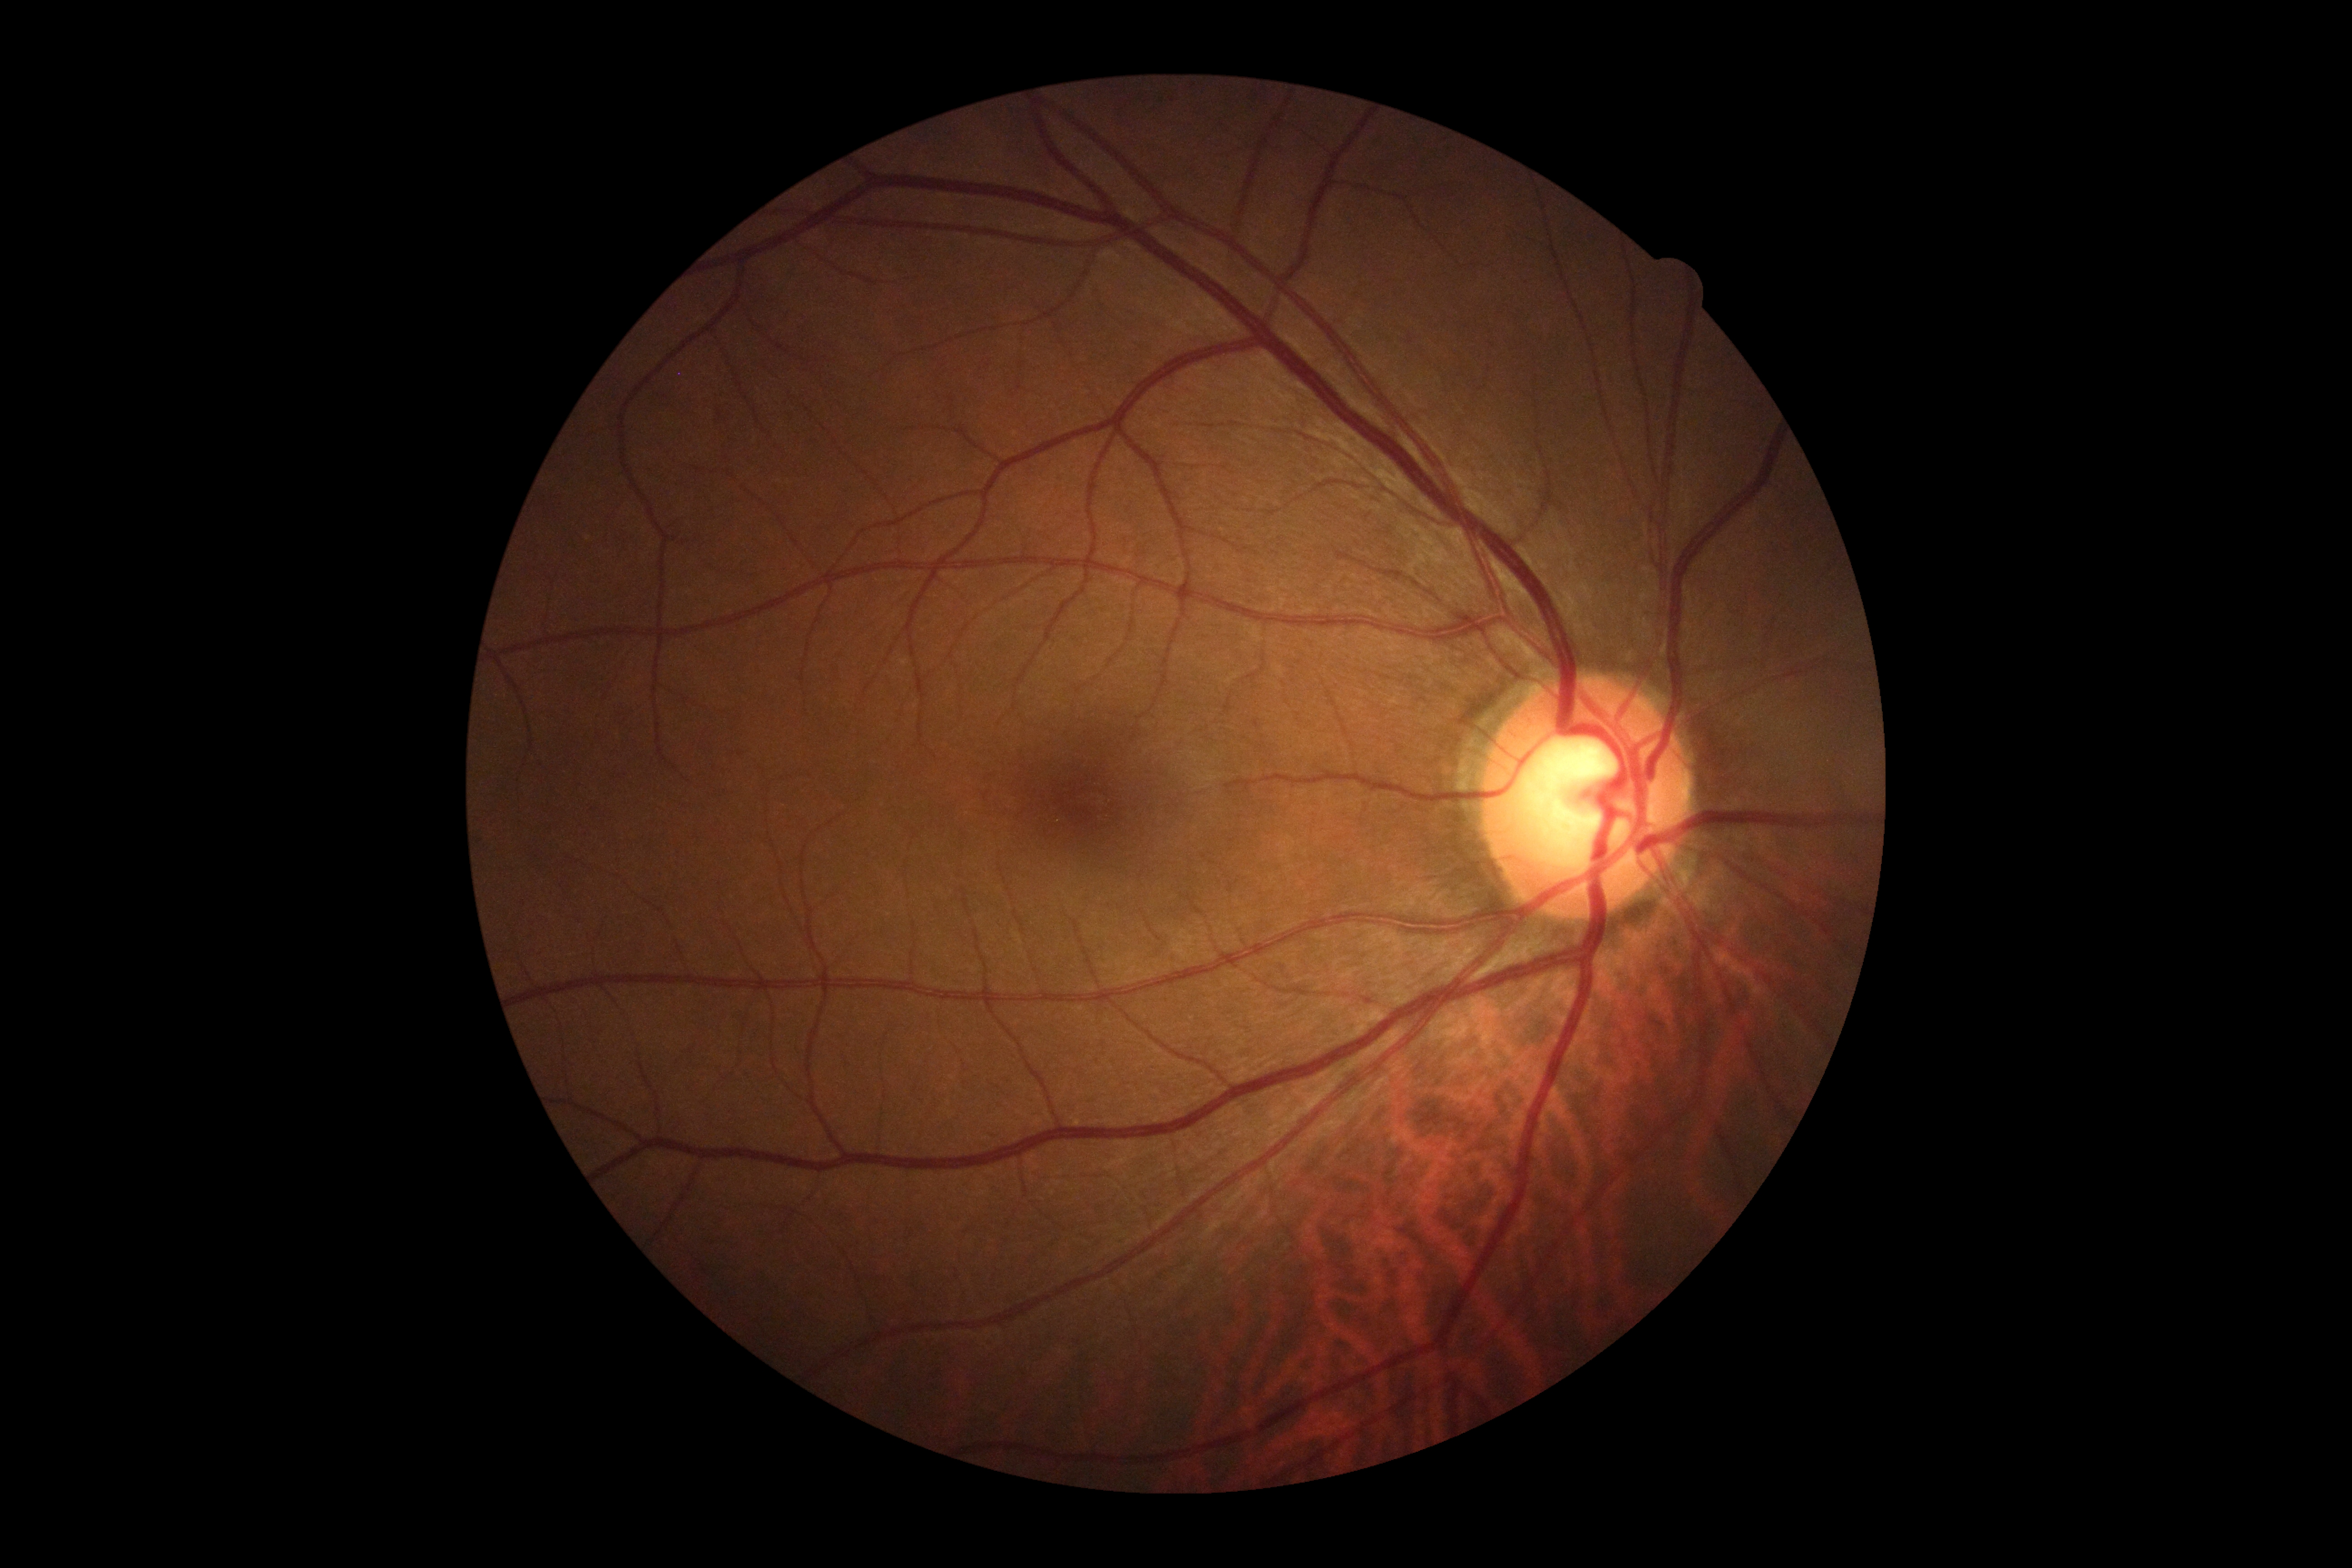 Diabetic retinopathy (DR) is grade 0 (no apparent retinopathy).